Infant wide-field retinal image: 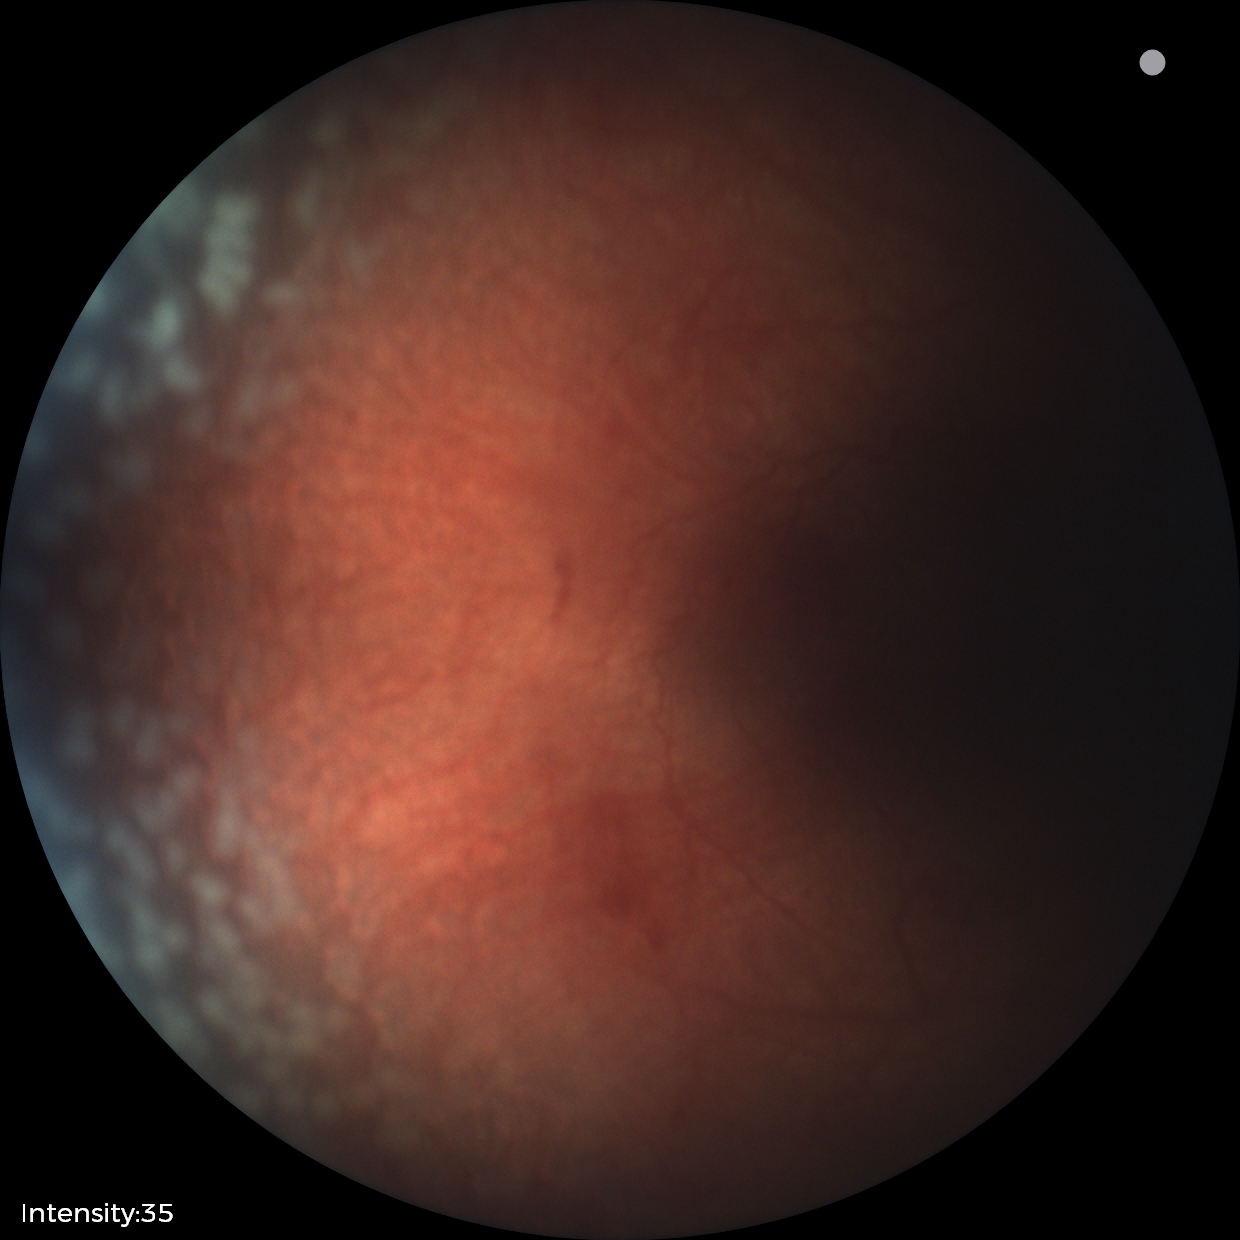

Screening examination consistent with retinopathy of prematurity (ROP) stage 2. Plus disease present.